FOV: 45 degrees; image size 1932x1910:
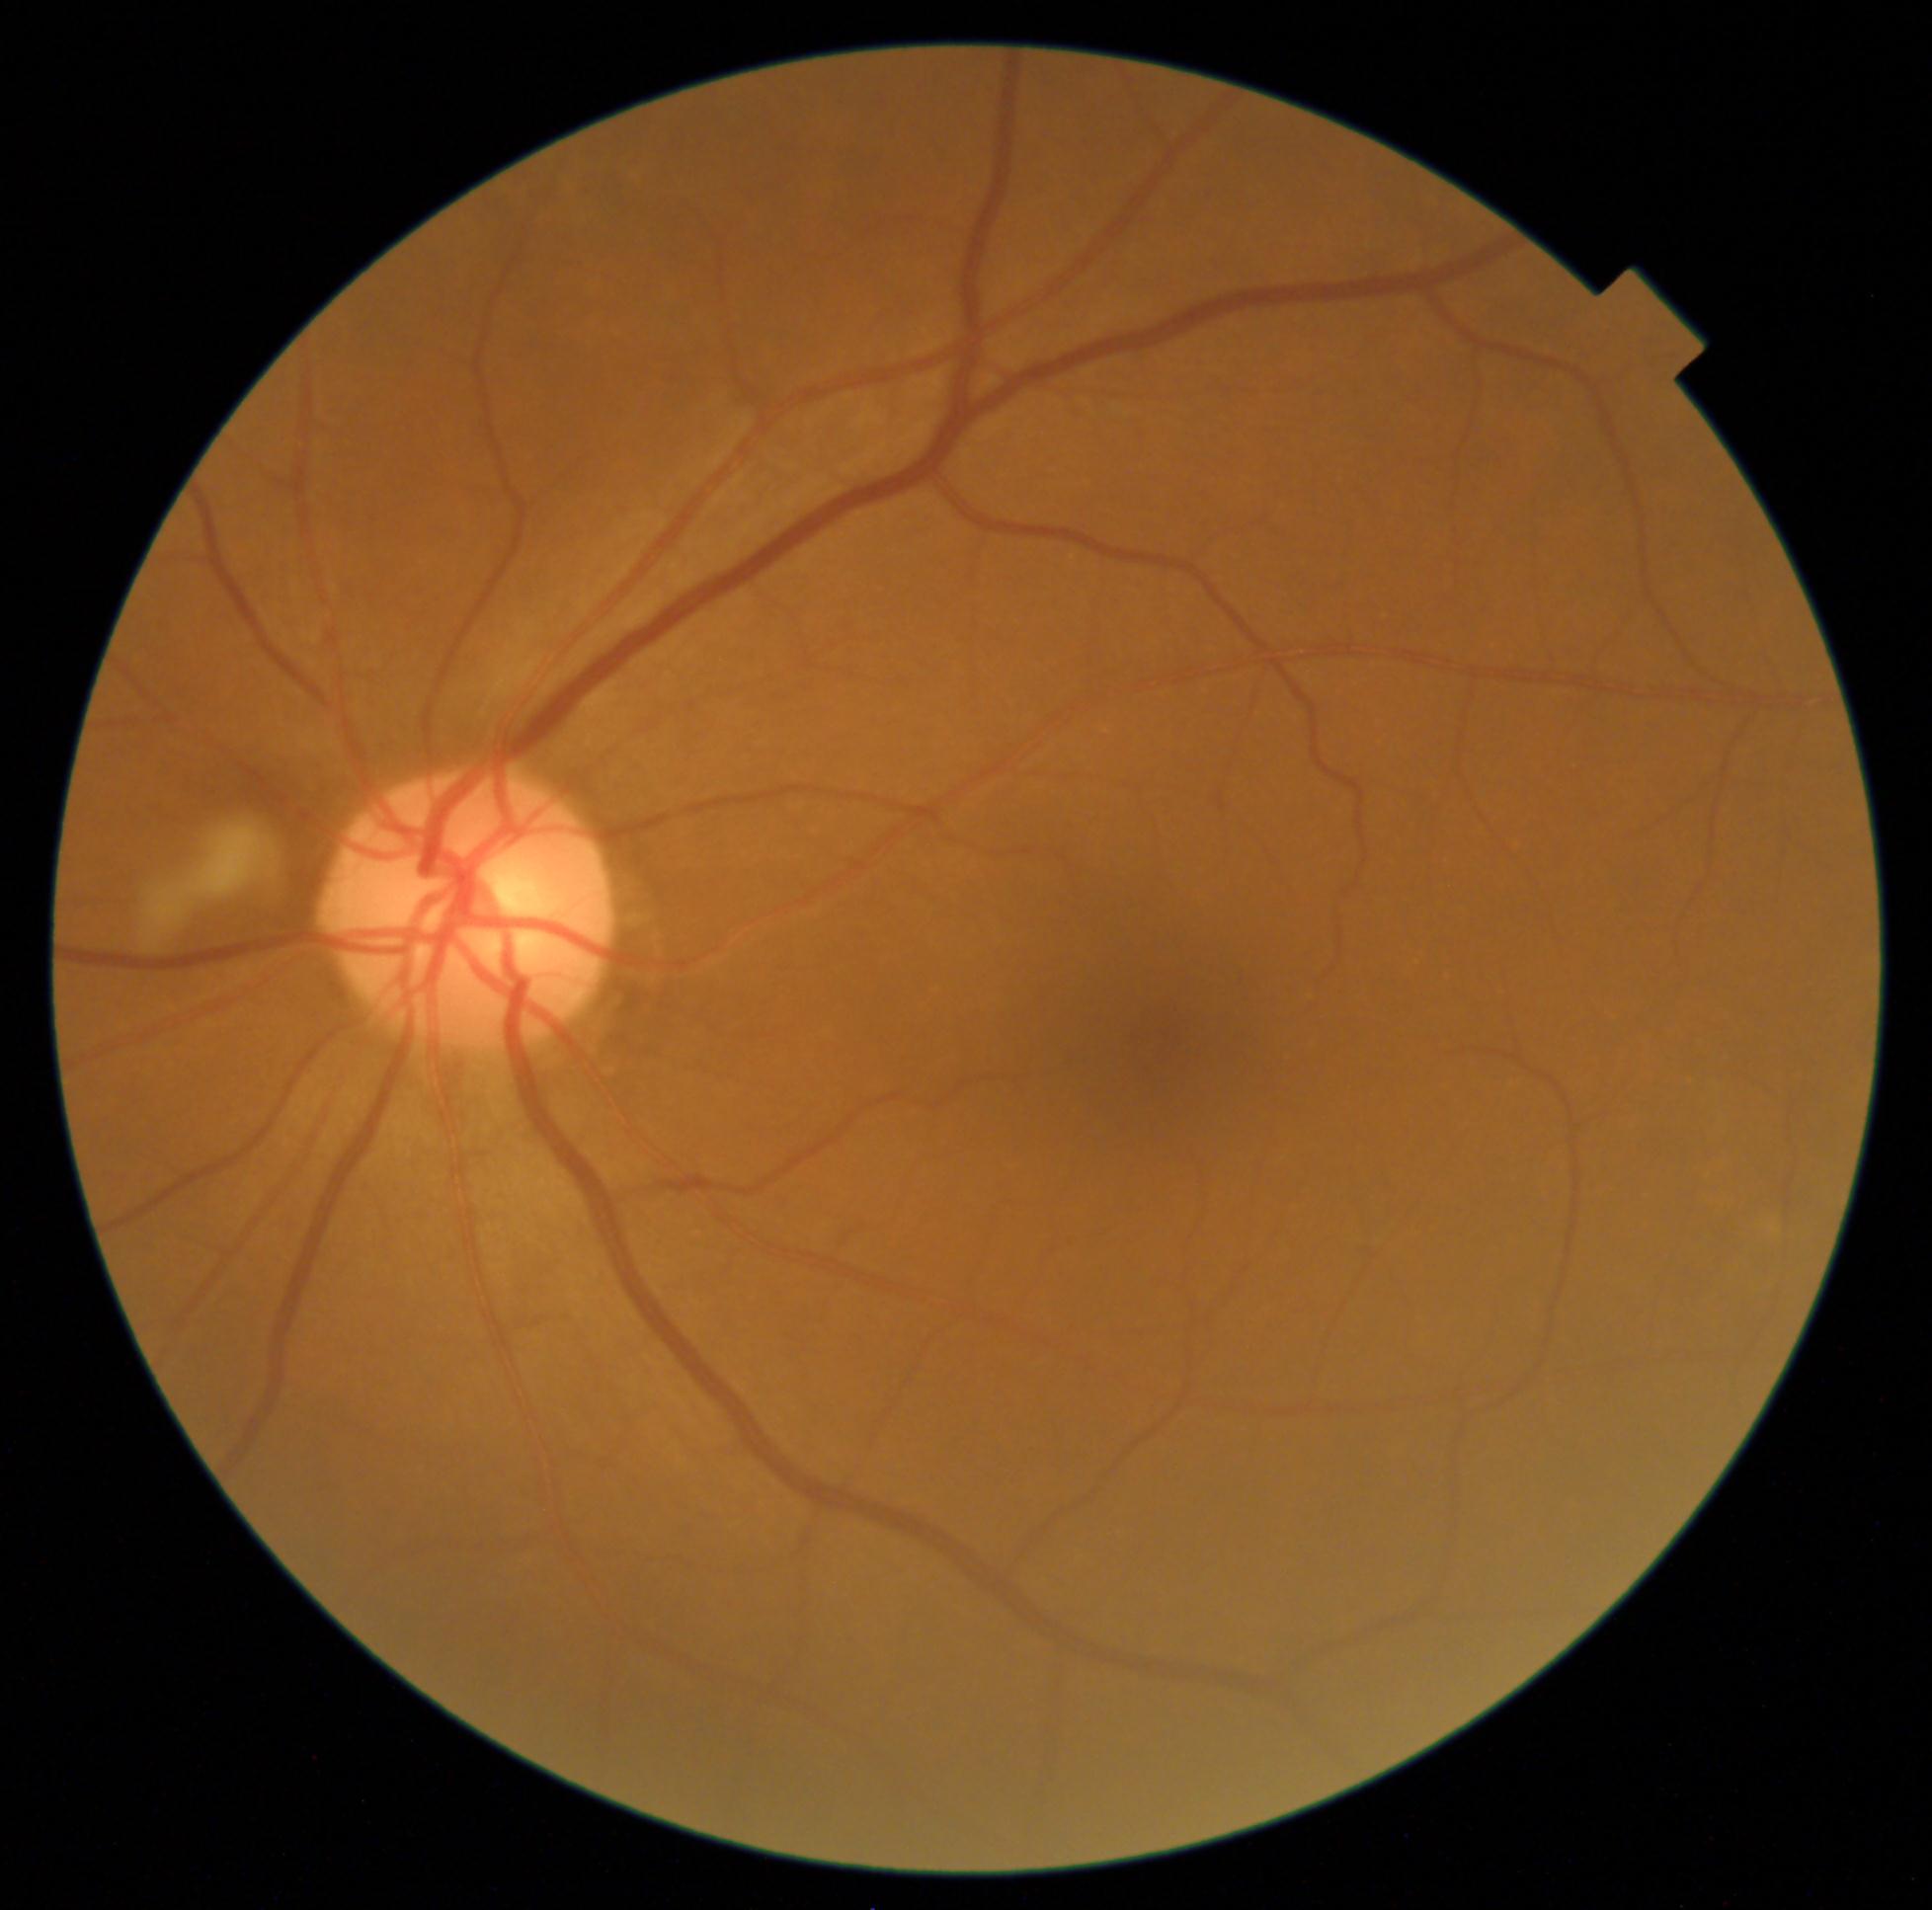 DR grade is no apparent diabetic retinopathy (0).